Dilated pupil, fundus photograph cropped around the optic nerve head, 337x337
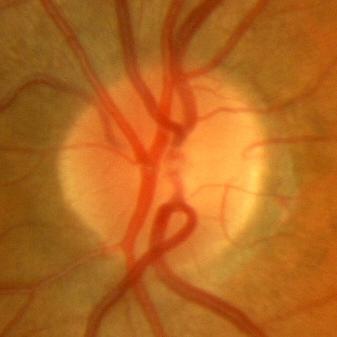
Demonstrates no signs of glaucoma.